Ultra-widefield (UWF) fundus image
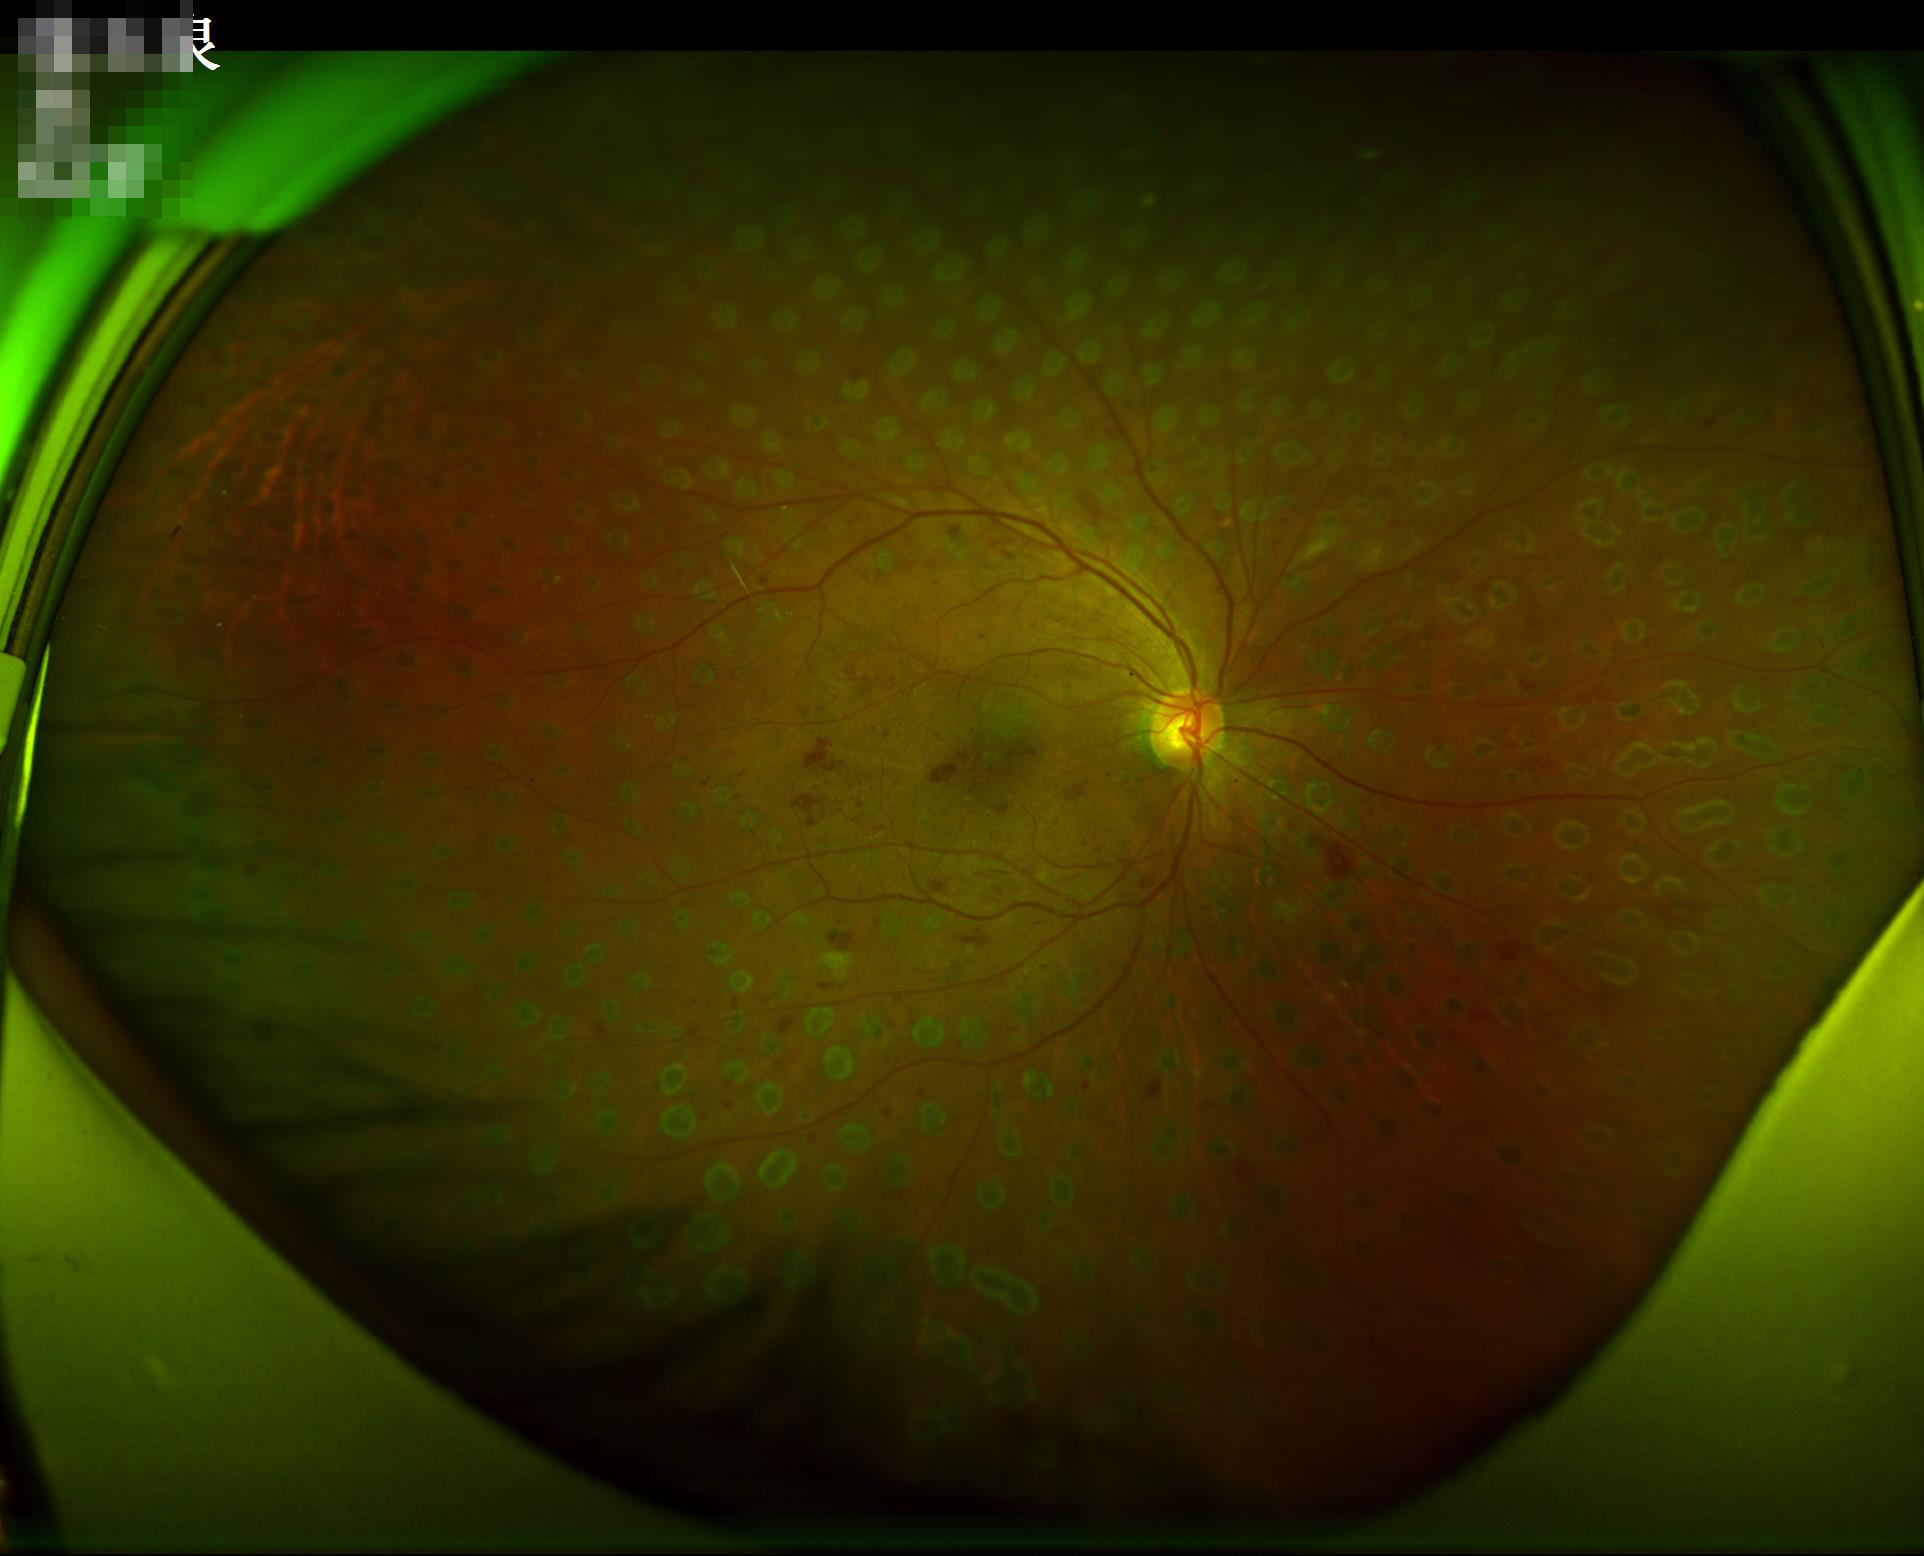
Contrast is good. Even illumination with no color cast. Overall quality is good and the image is gradable. The image is clear.